Image size 2352x1568.
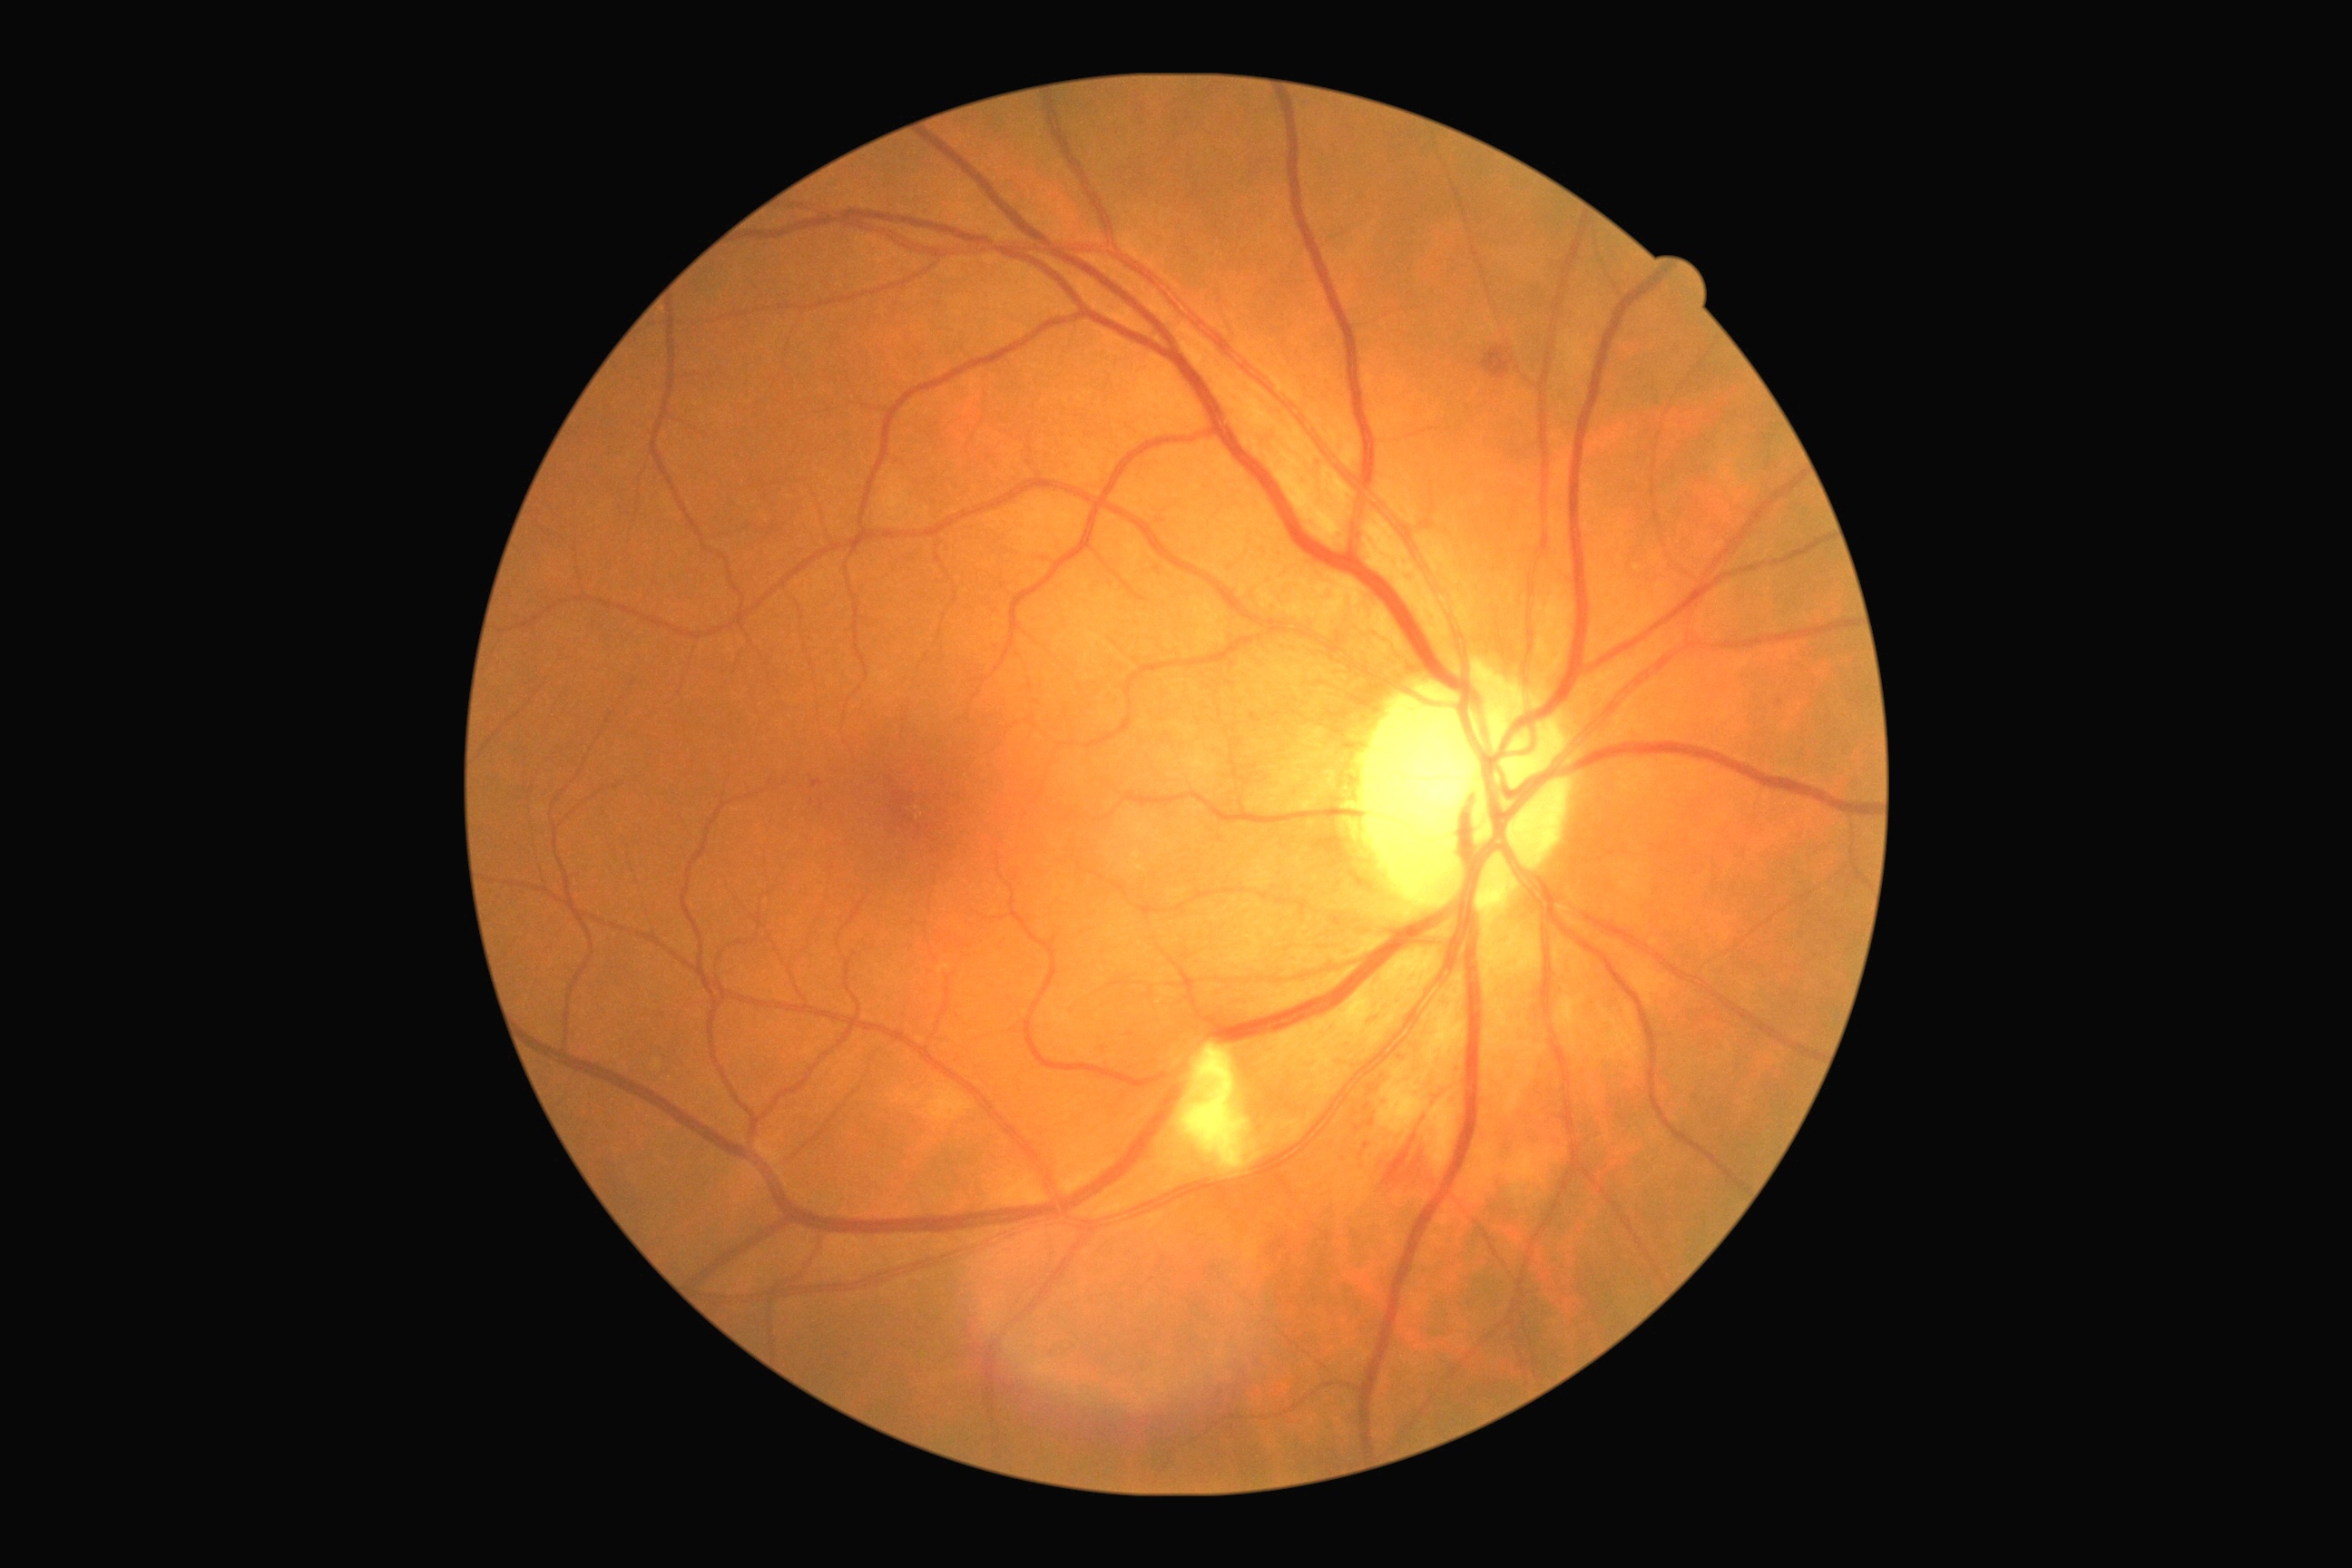 DR stage: grade 2 (moderate NPDR)
EXs: none
SEs: (left=1179, top=1044, right=1250, bottom=1173)
MAs: (left=1367, top=1084, right=1373, bottom=1093); (left=812, top=781, right=821, bottom=789); (left=1367, top=1119, right=1375, bottom=1128); (left=1366, top=1104, right=1371, bottom=1112); (left=1364, top=1142, right=1369, bottom=1150)
Small MAs near (x=1780, y=703)
HEs: (left=1387, top=1142, right=1436, bottom=1195); (left=1482, top=348, right=1513, bottom=380)